45-degree field of view. Fundus photo
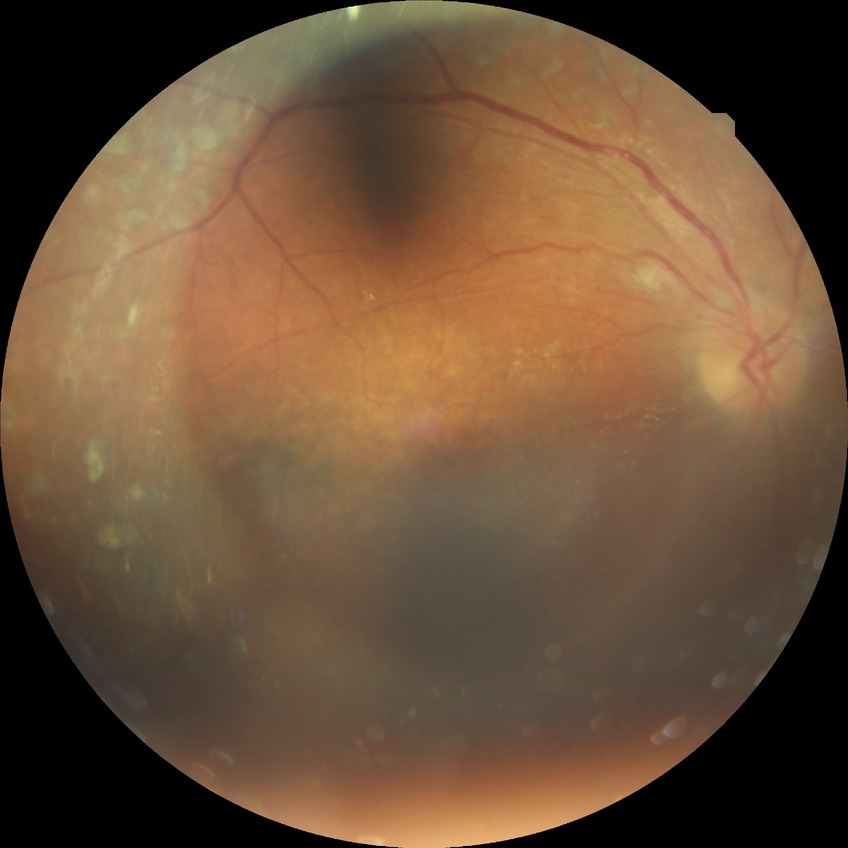

Diabetic retinopathy (DR): proliferative diabetic retinopathy (PDR).